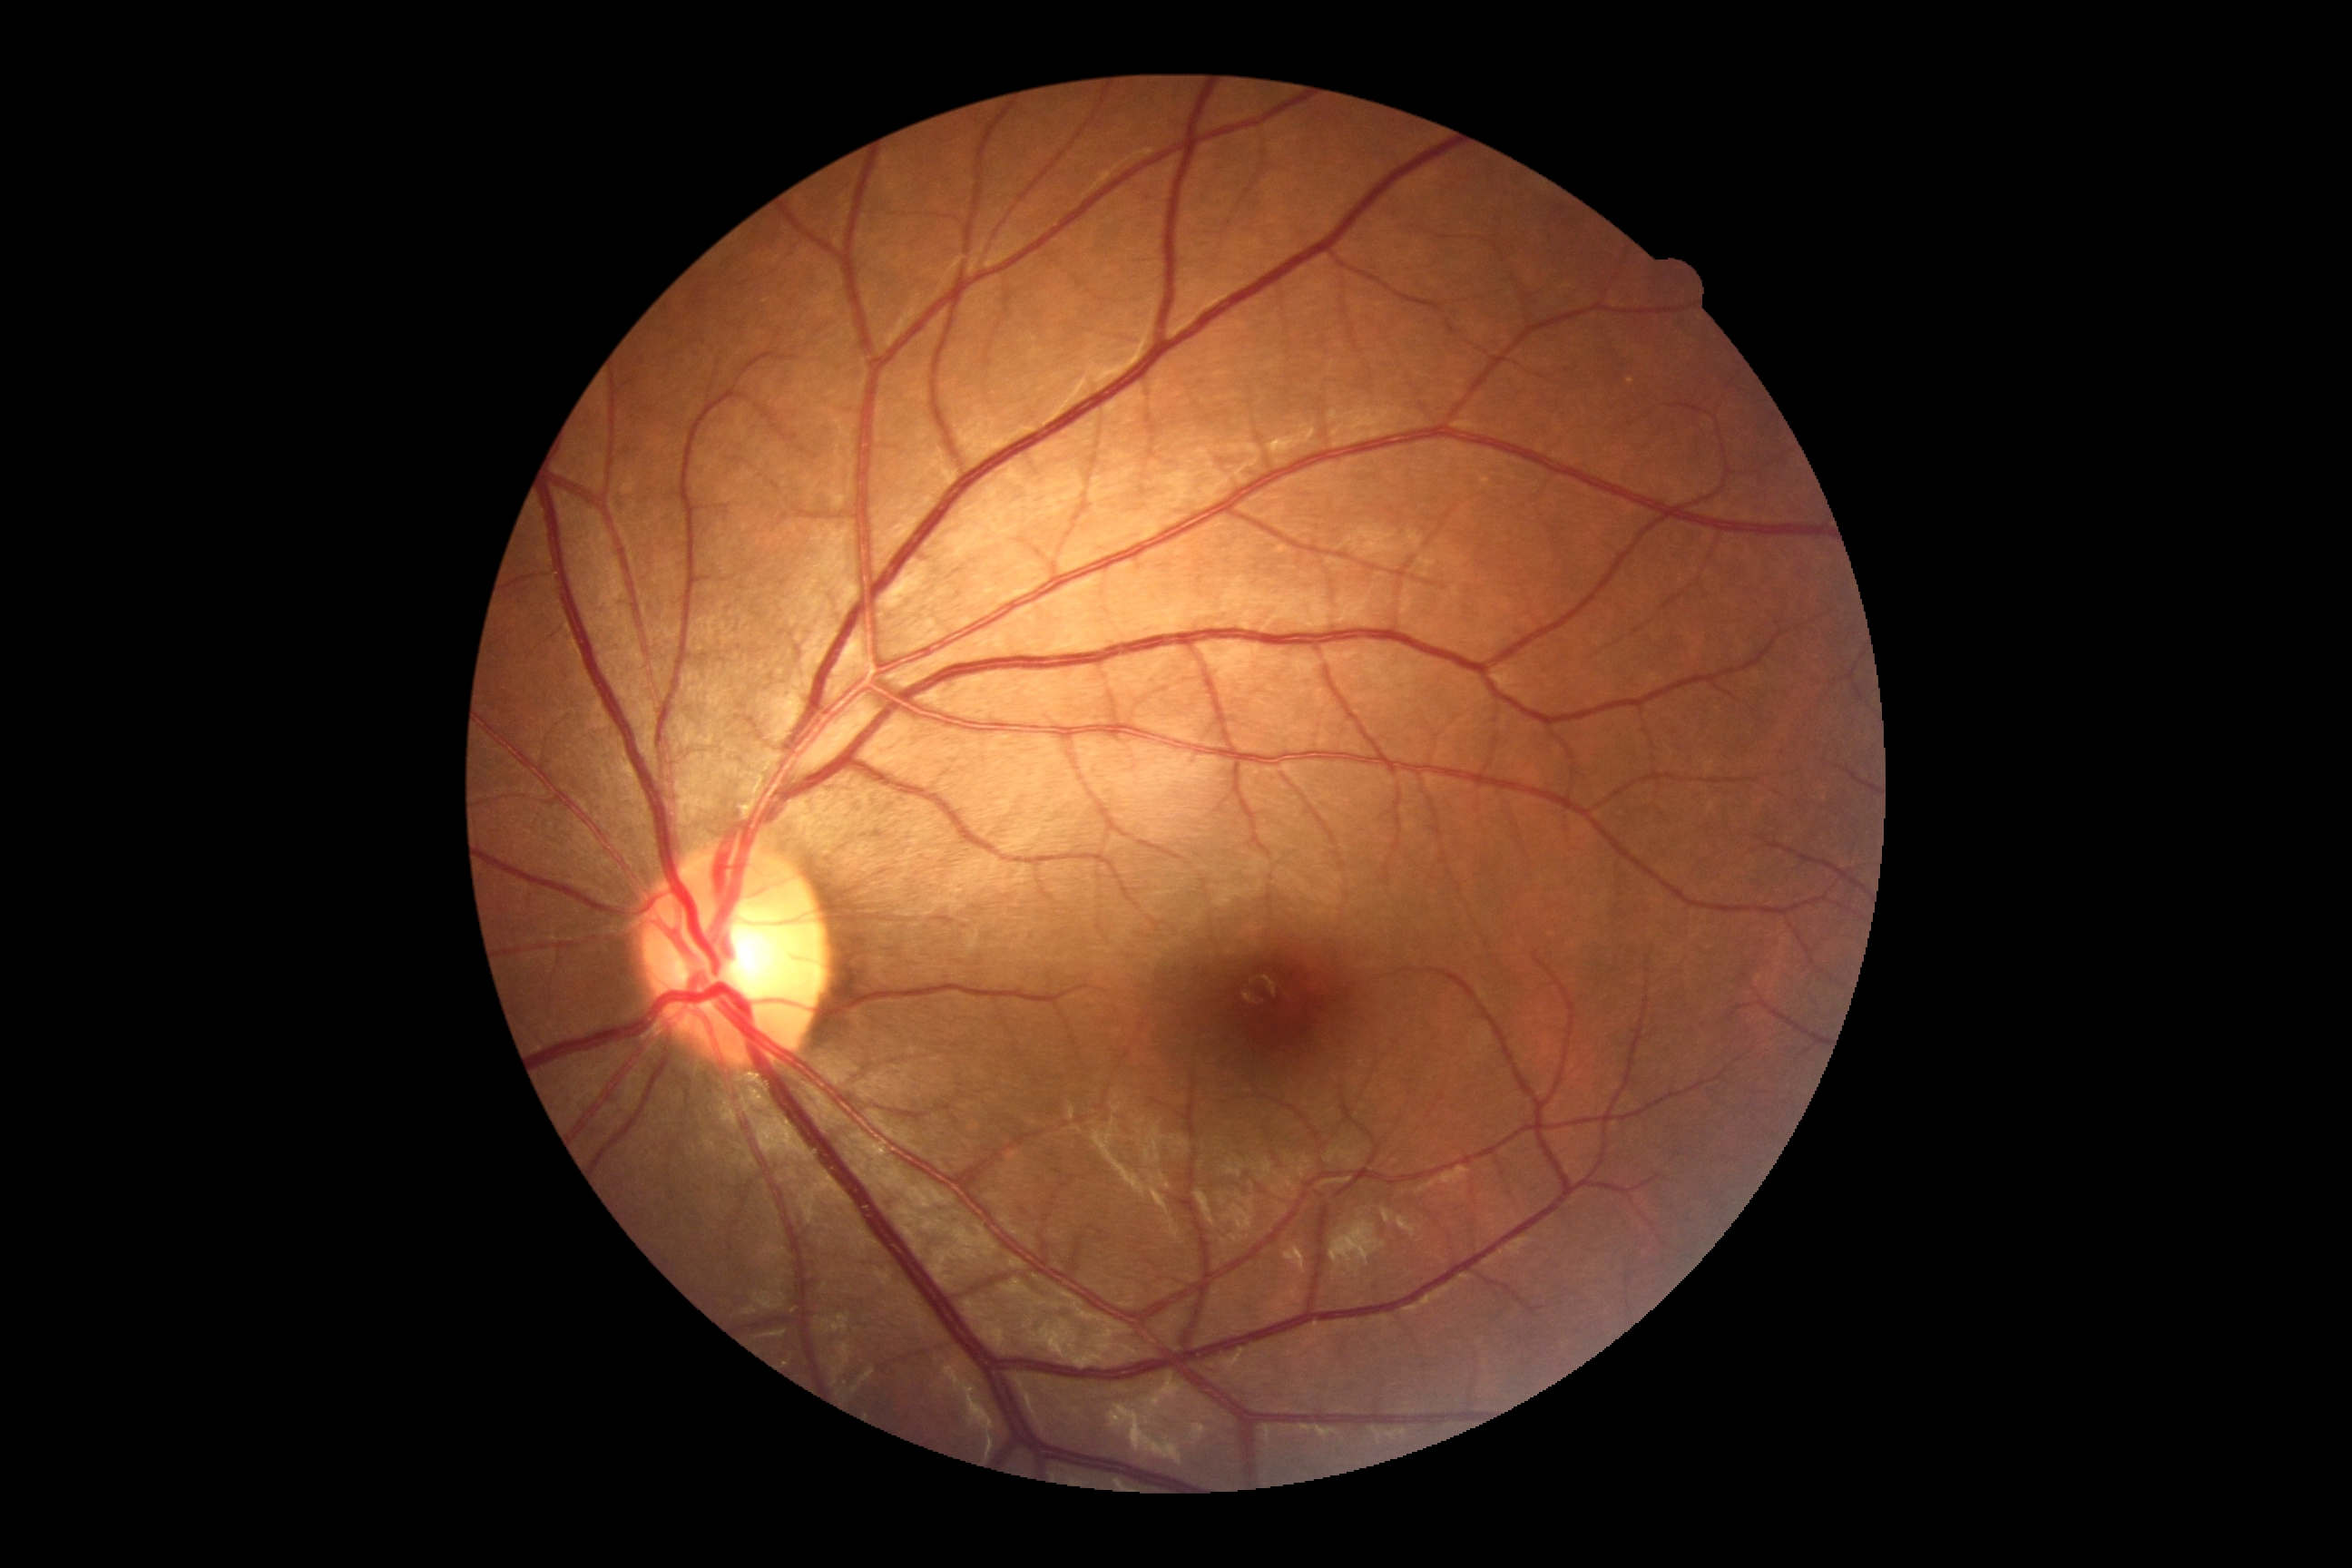
retinopathy: grade 0 (no apparent retinopathy).